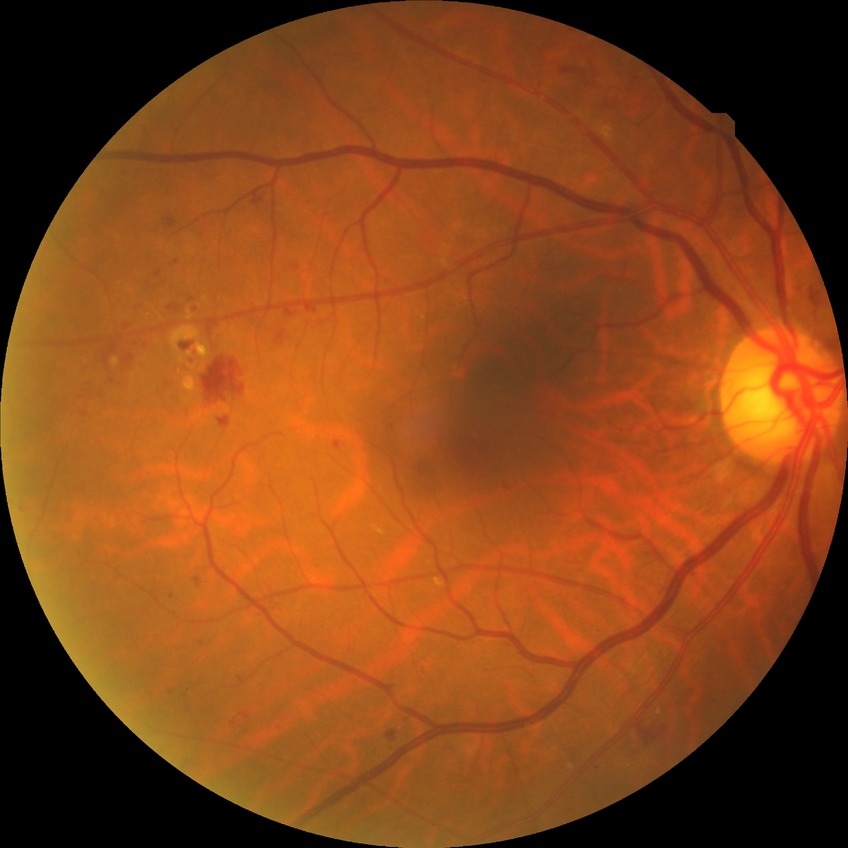

davis_grade: simple diabetic retinopathy (SDR)